Image size 512x512
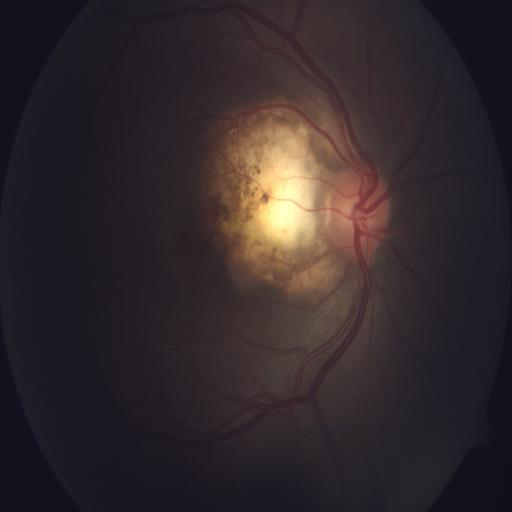 Pathology: CB (coloboma).